DR severity per modified Davis staging
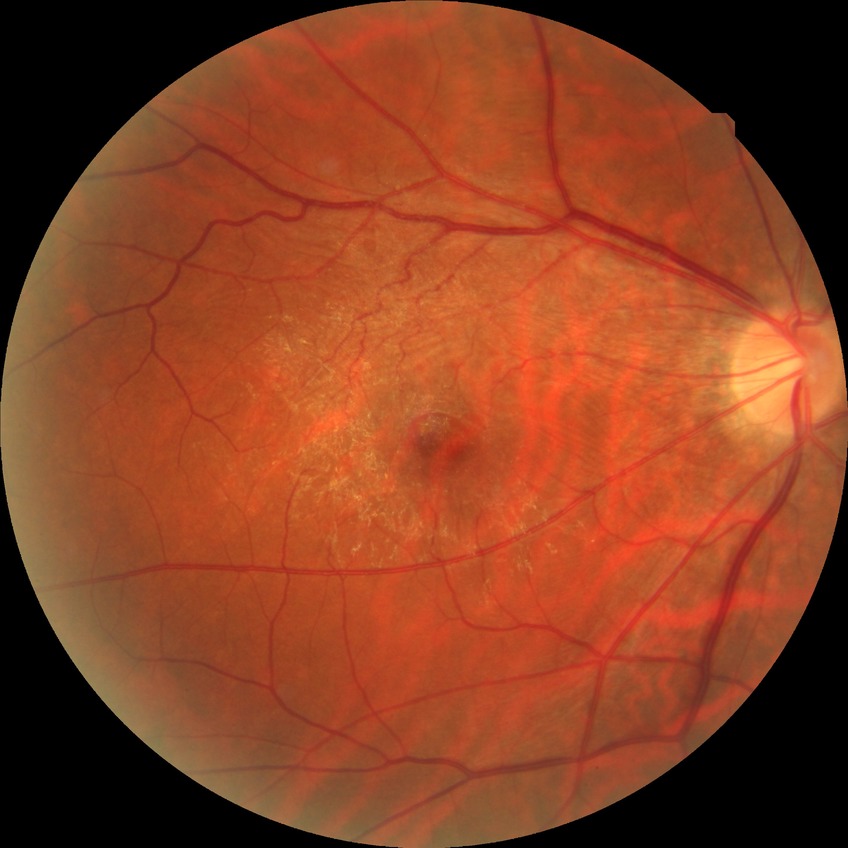

  davis_grade: no diabetic retinopathy